848 by 848 pixels; 45° field of view
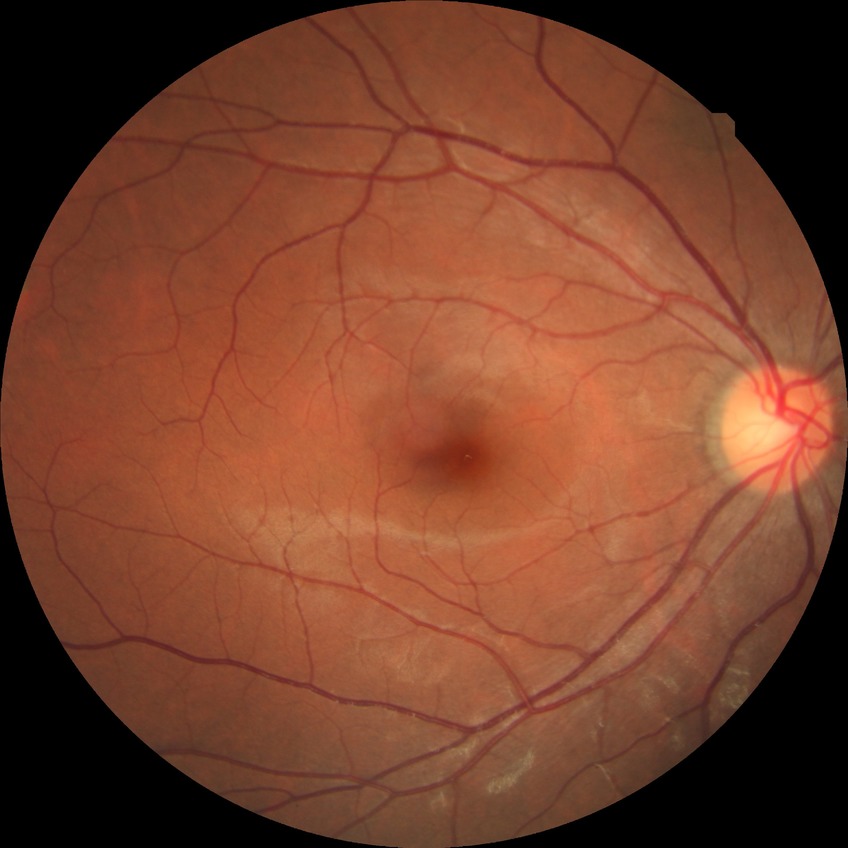 Diabetic retinopathy stage is no diabetic retinopathy.